2352x1568: 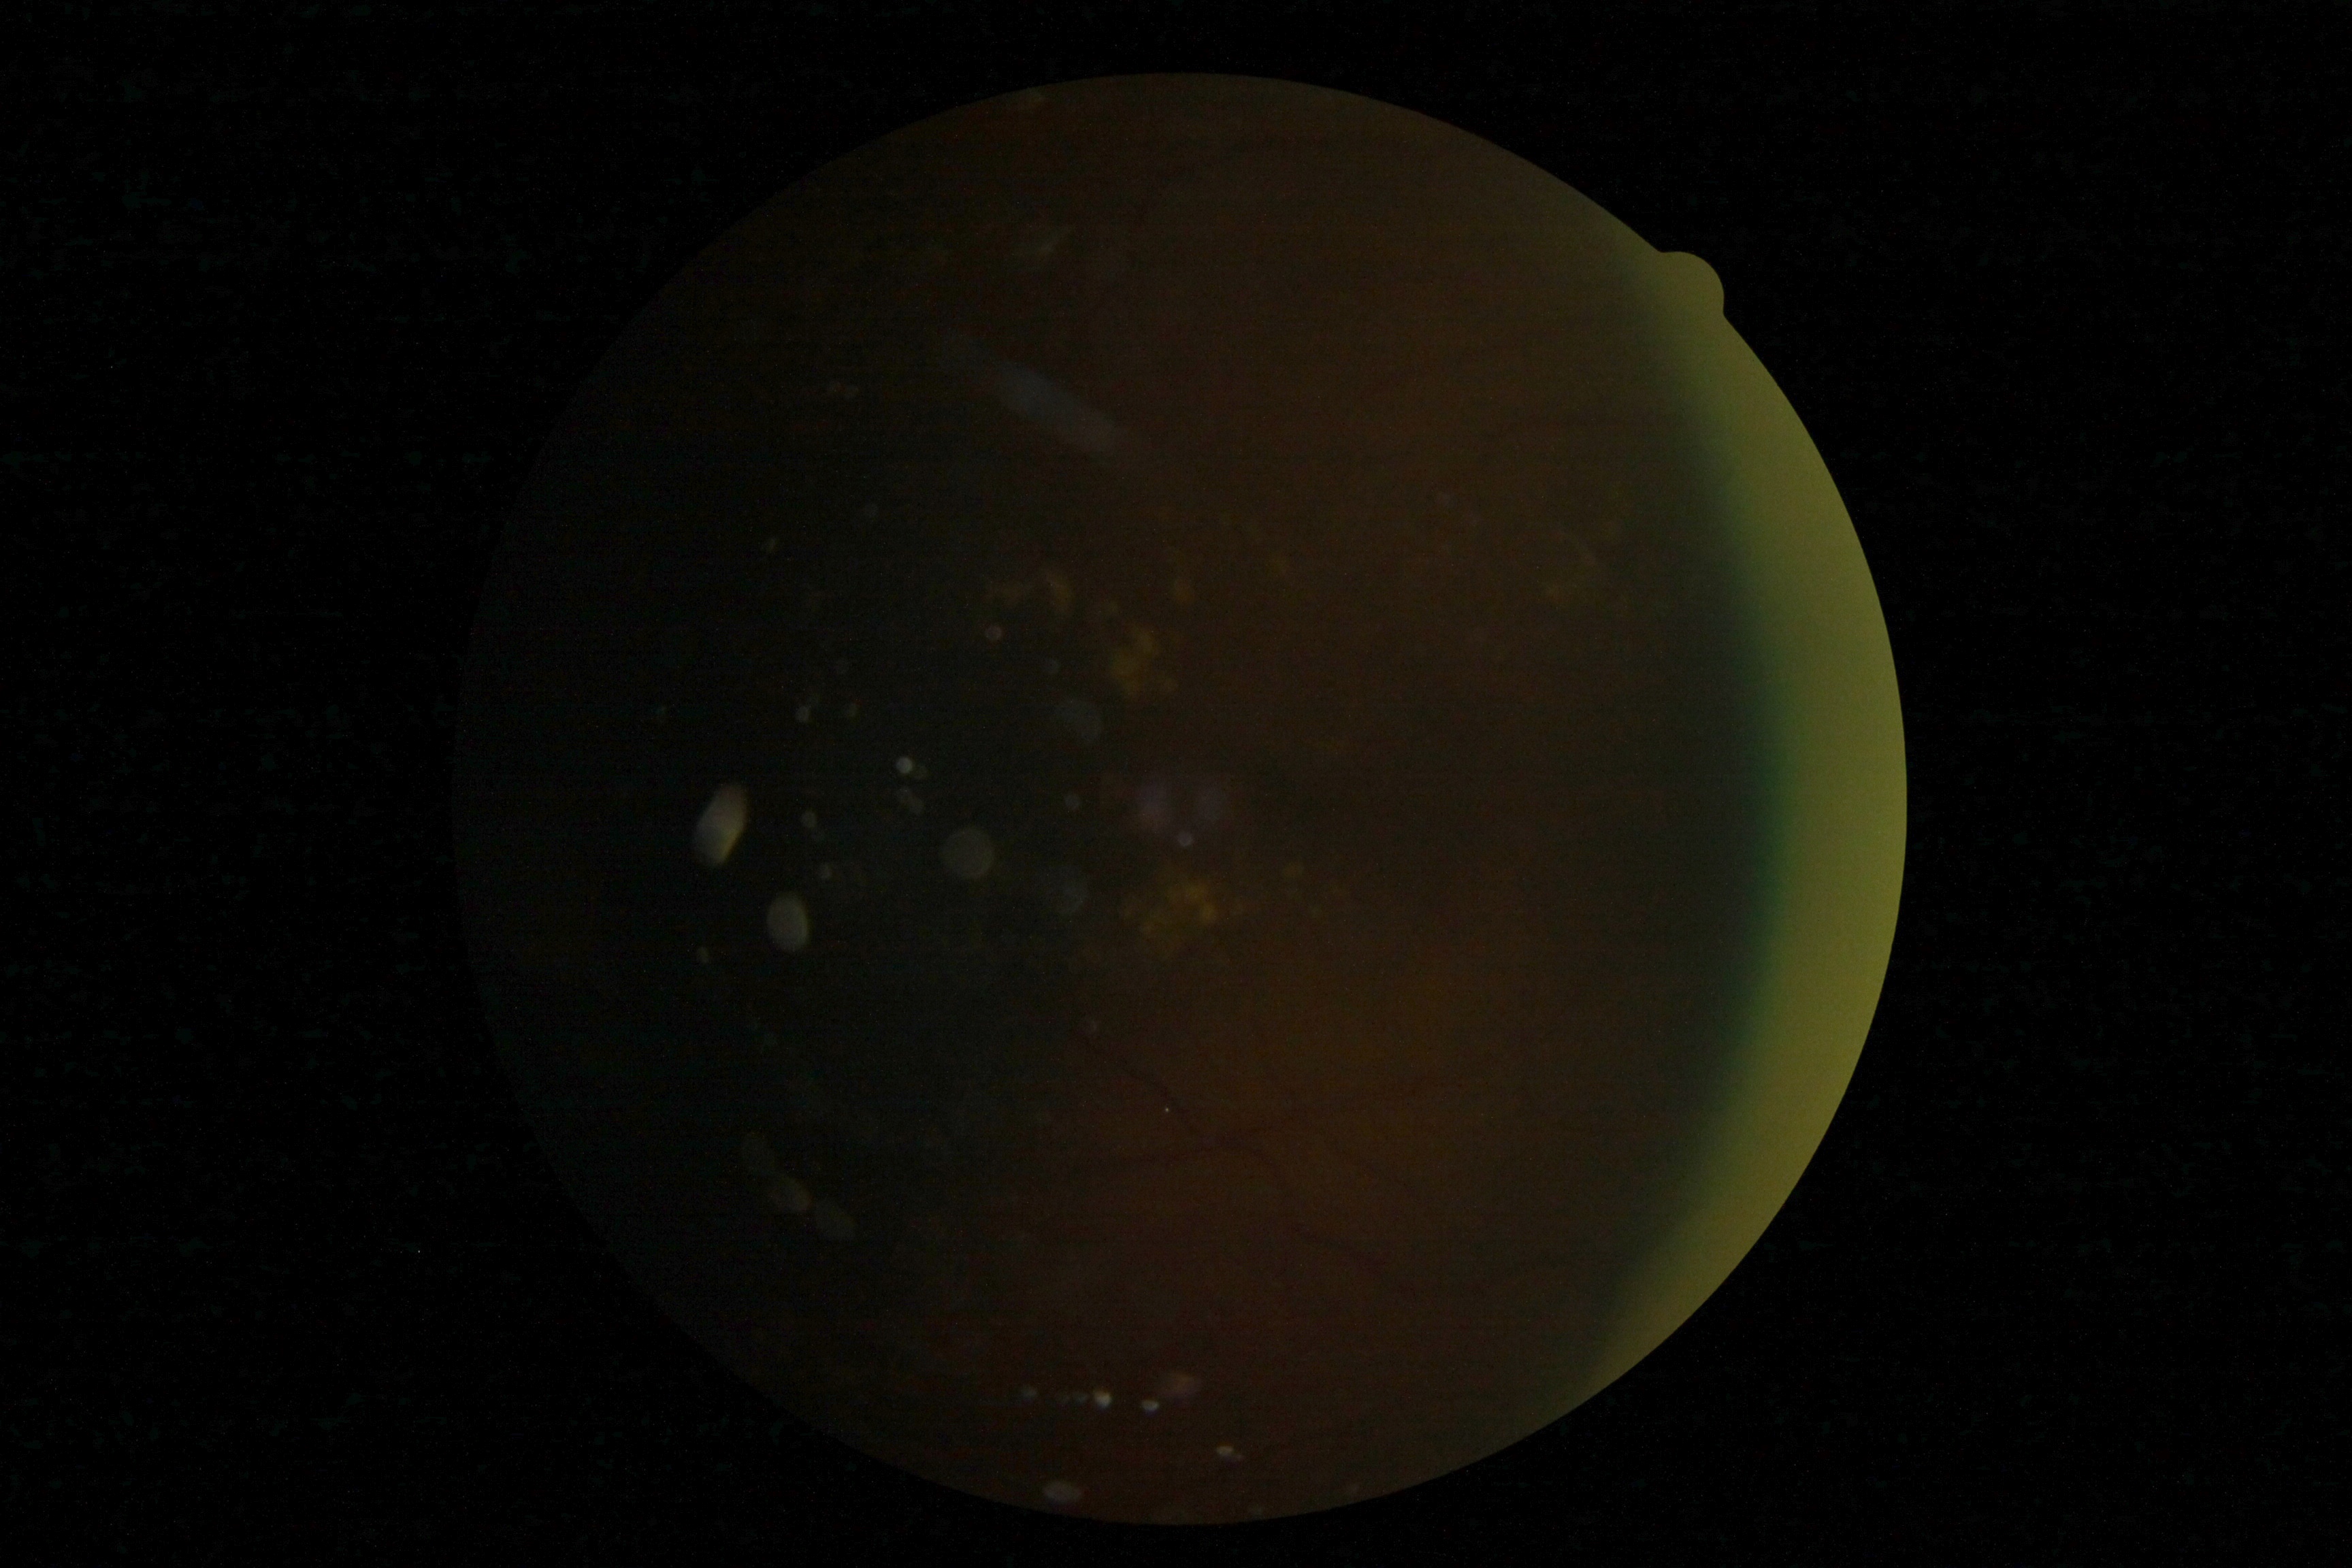 DR grade is ungradable due to poor image quality.